ONH-centered crop from a color fundus image; image size 1420x1420.
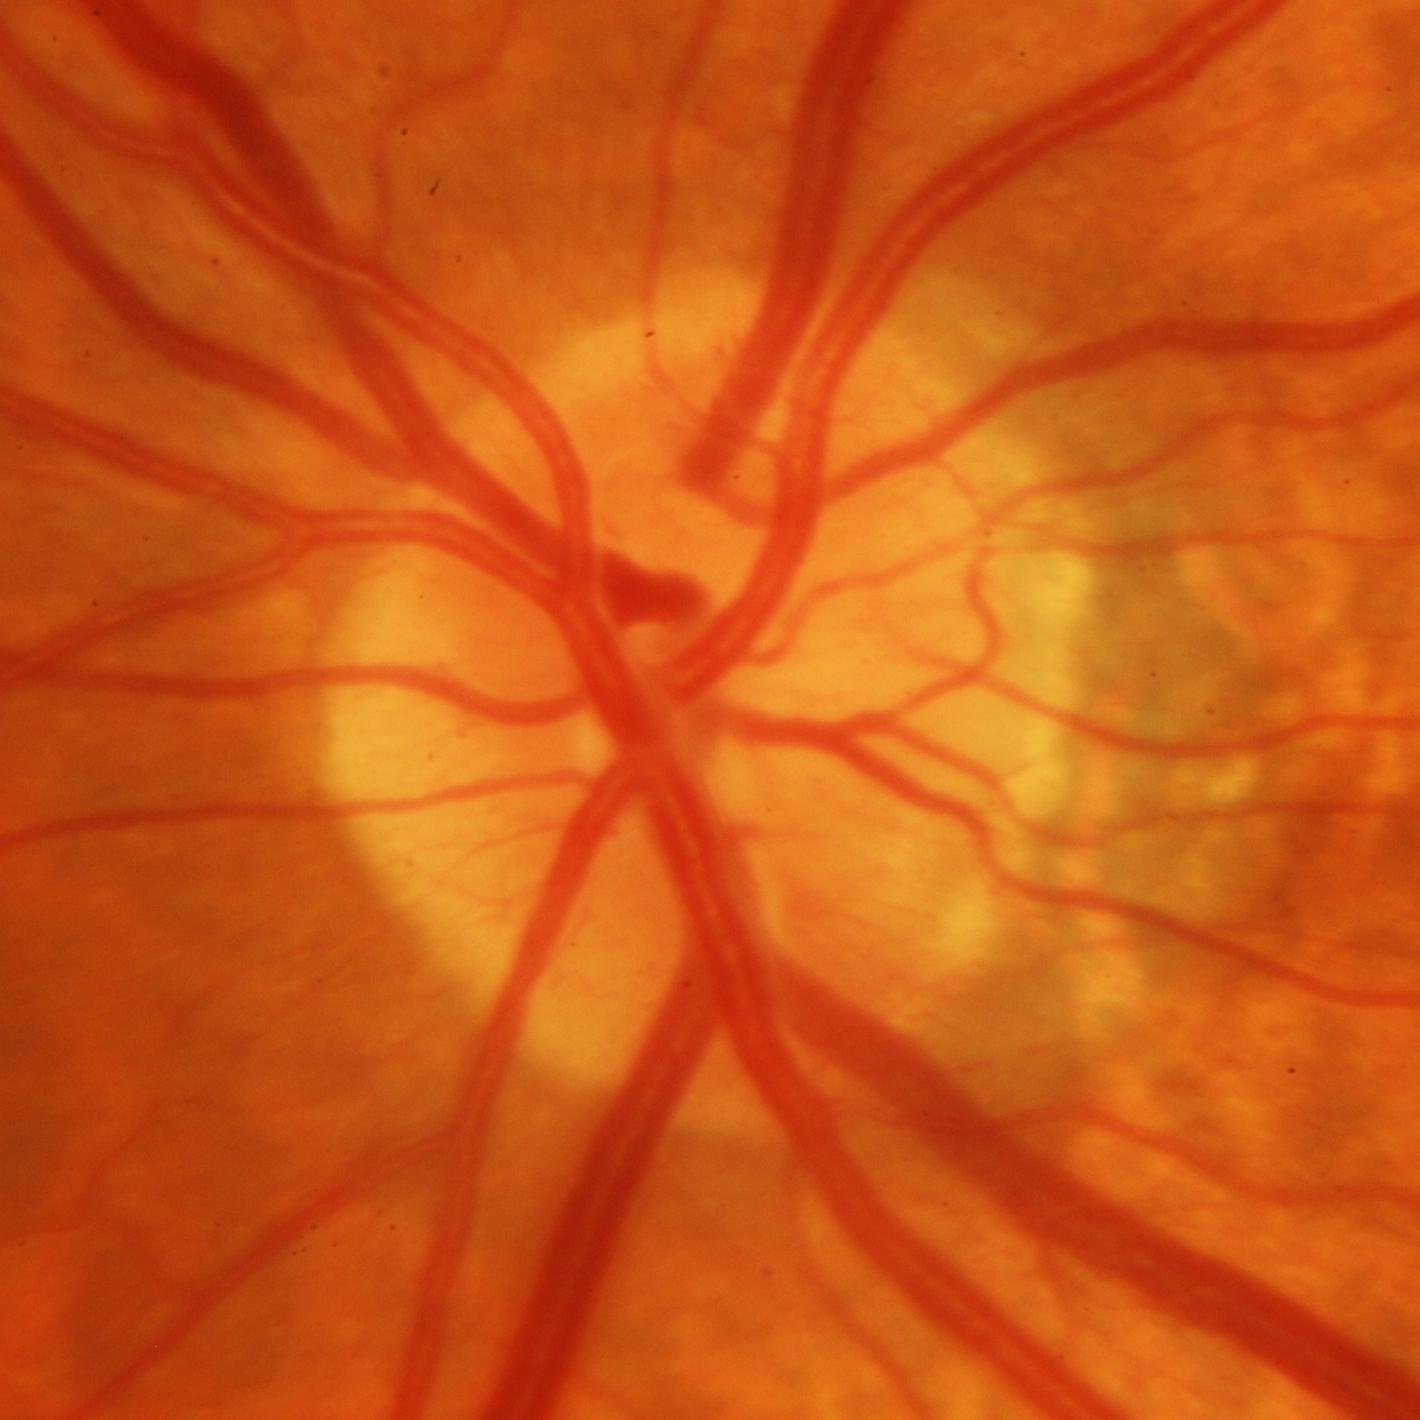 Glaucoma is present.
Glaucomatous damage to the optic nerve.